FOV: 45 degrees: 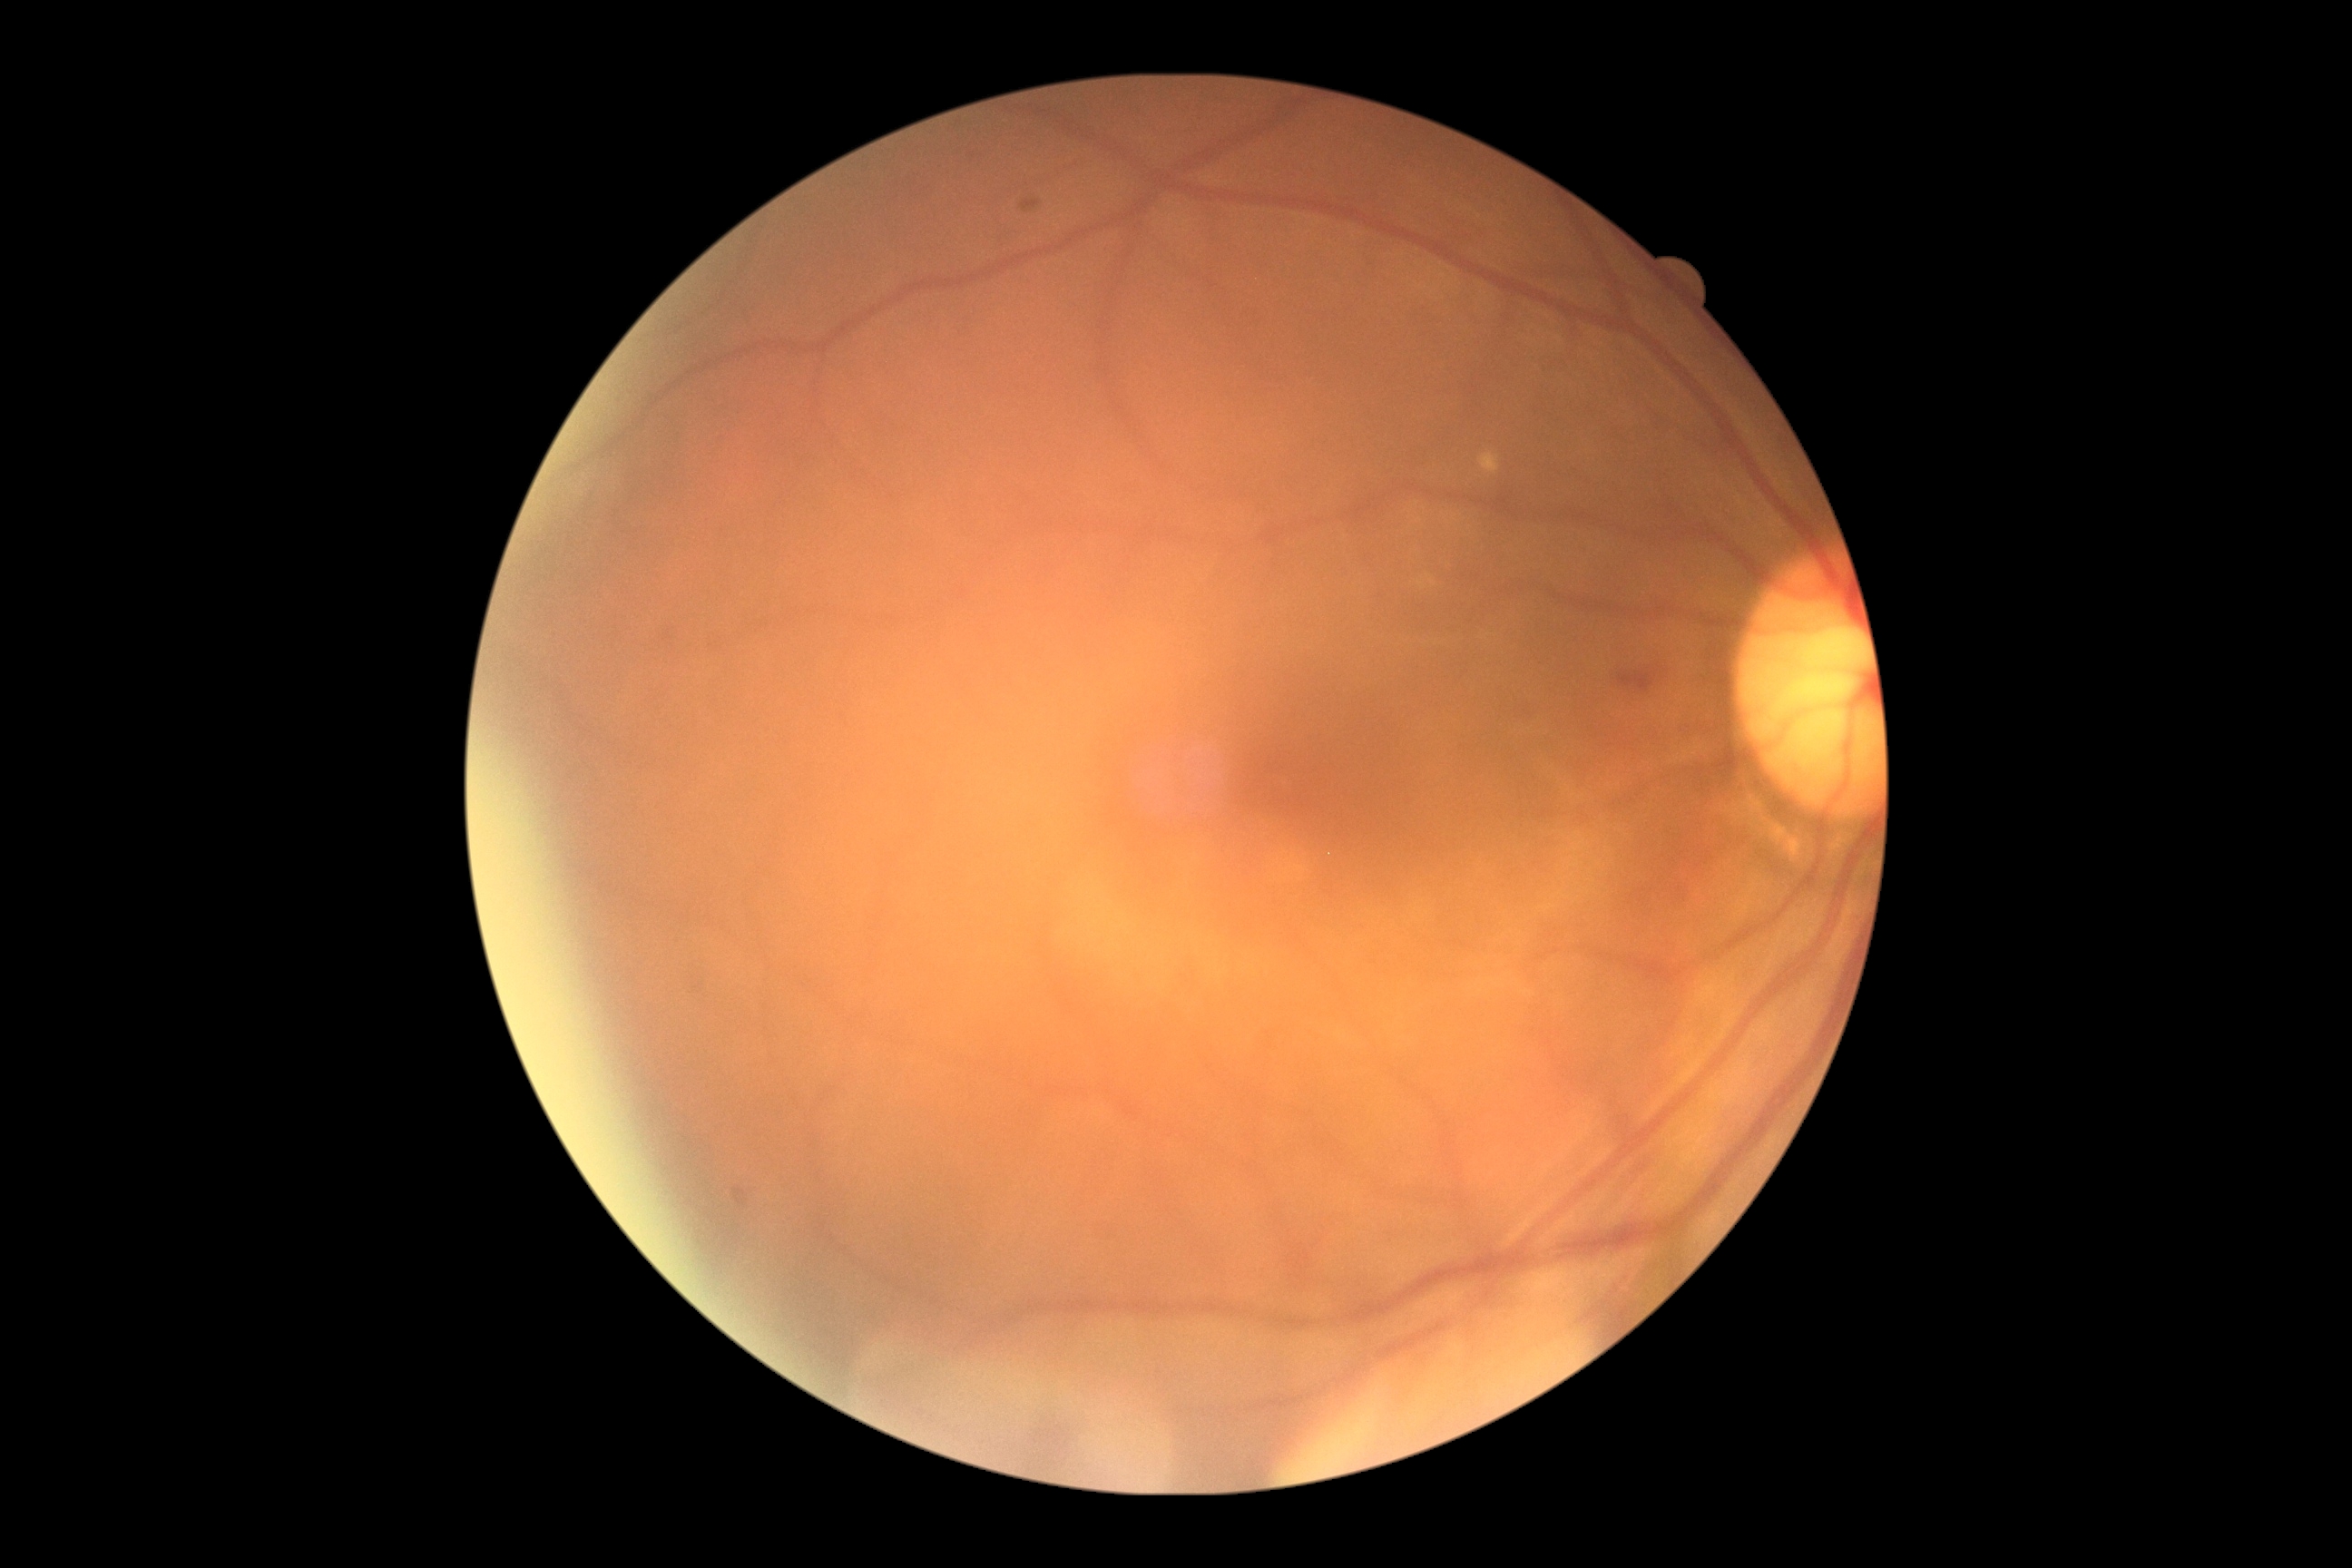
DR severity = moderate non-proliferative diabetic retinopathy (grade 2) | DR class = non-proliferative diabetic retinopathy.